Fundus image cropped to the optic disc: 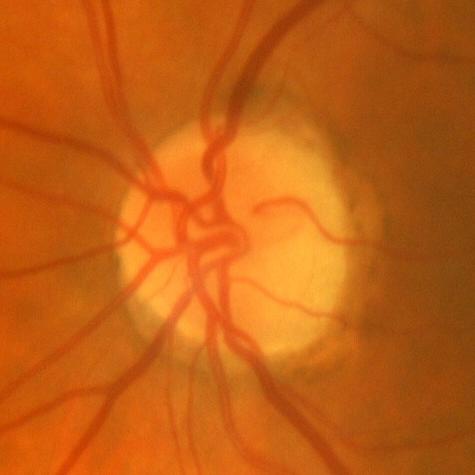

Glaucoma diagnosis: no glaucomatous optic neuropathy.